Graded on the modified Davis scale:
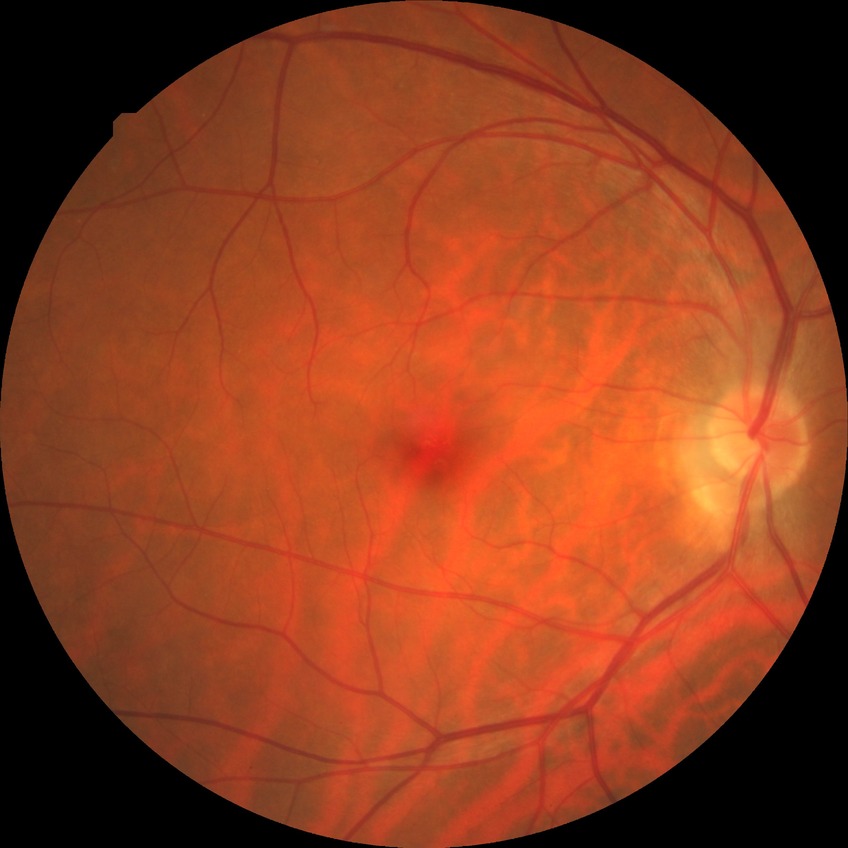
Findings:
- DR stage: NDR